Image size 1920x1440.
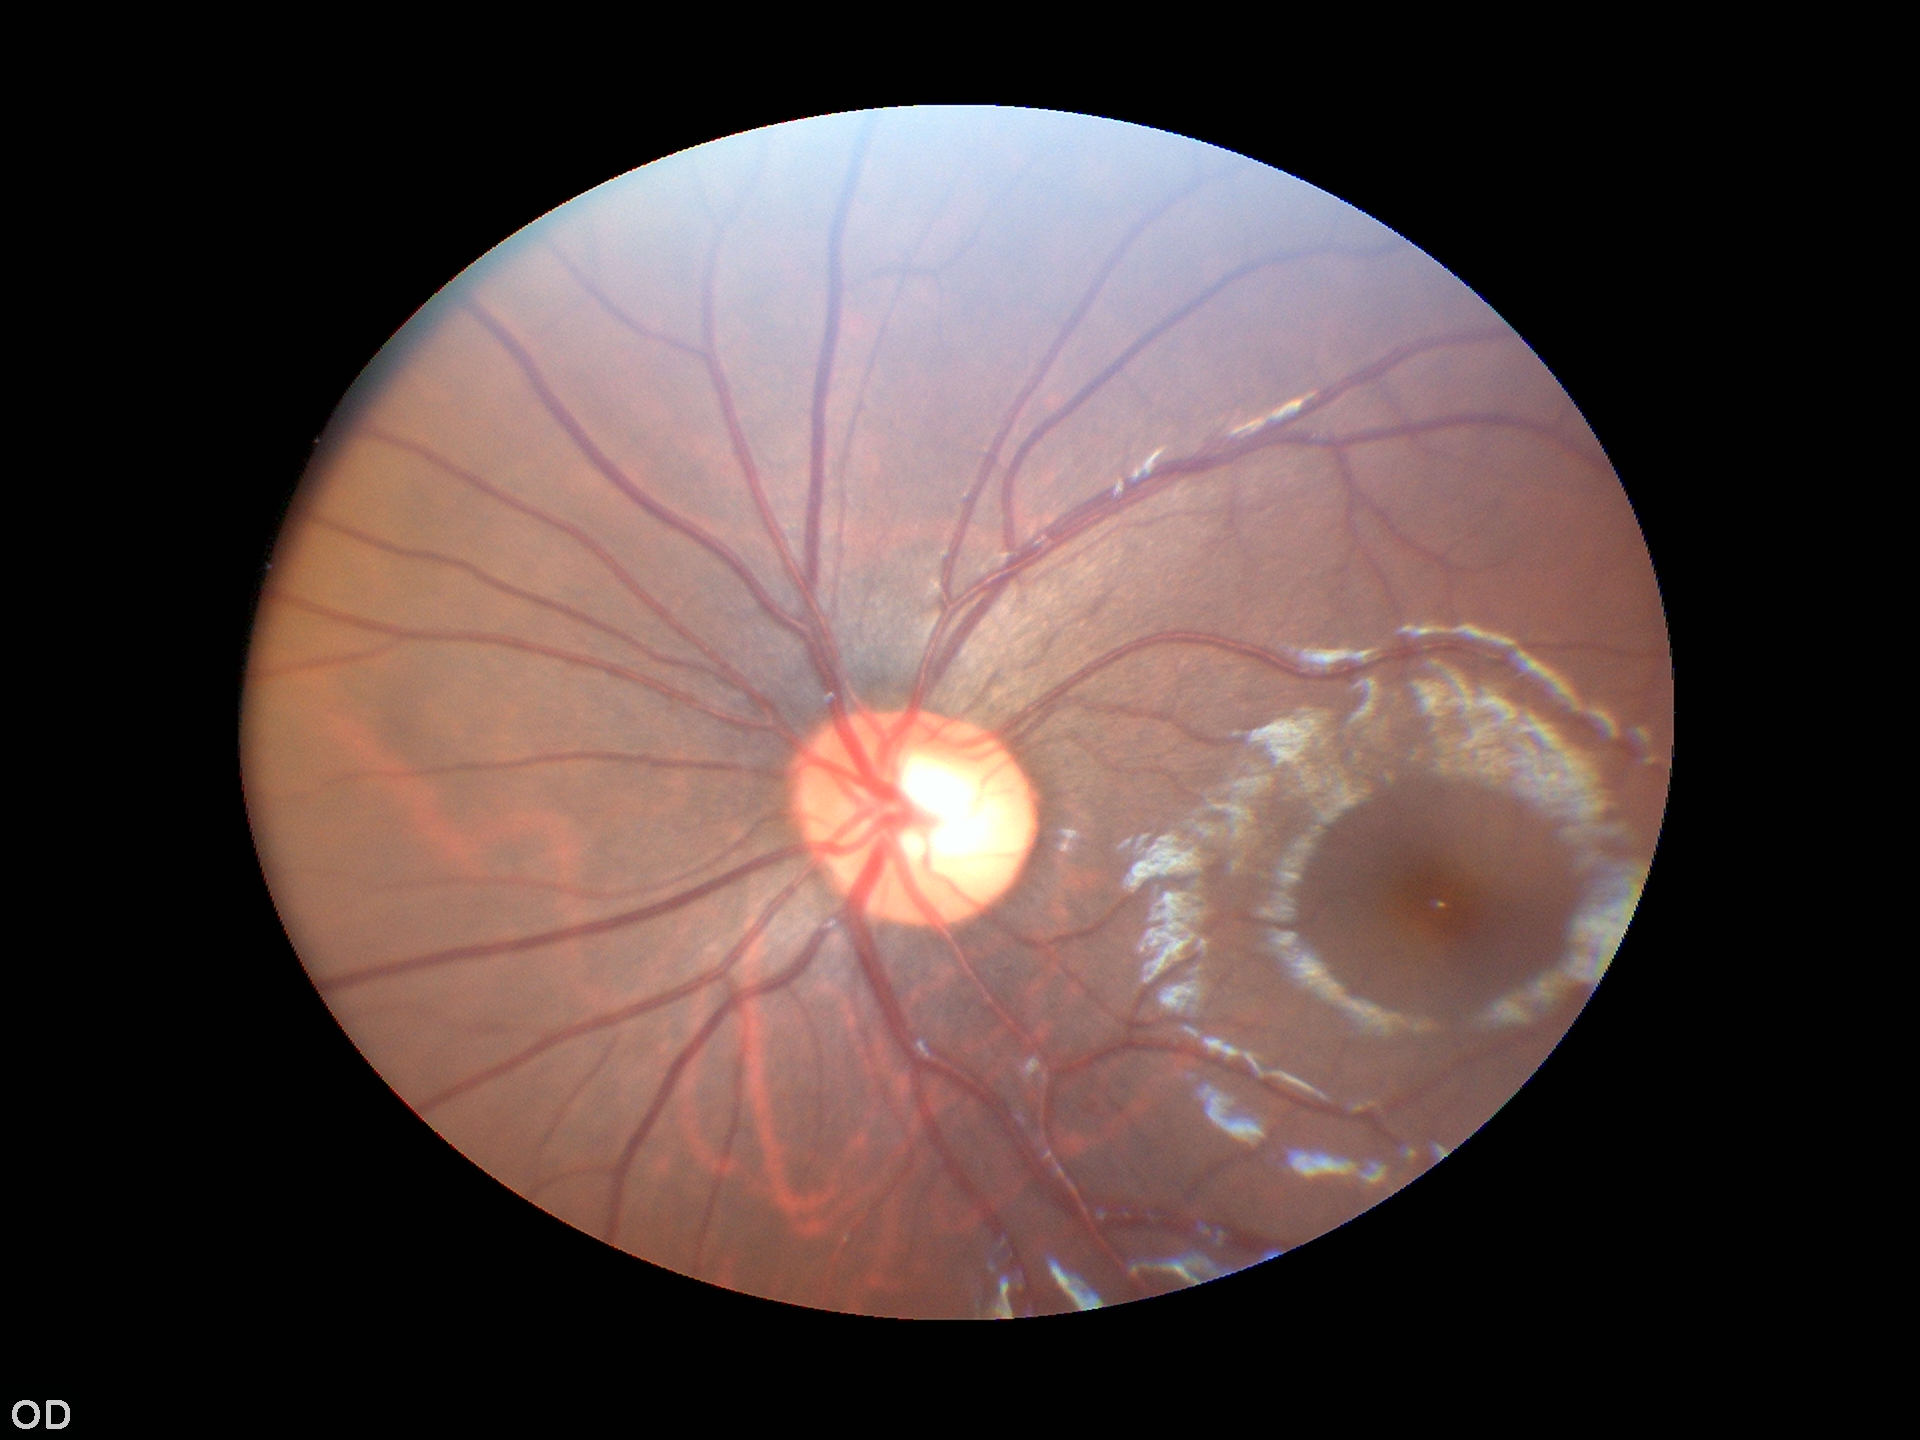 Annotations:
– Glaucoma assessment · not suspect
– vertical cup-disc ratio · 0.59
– horizontal cup-to-disc ratio · 0.58